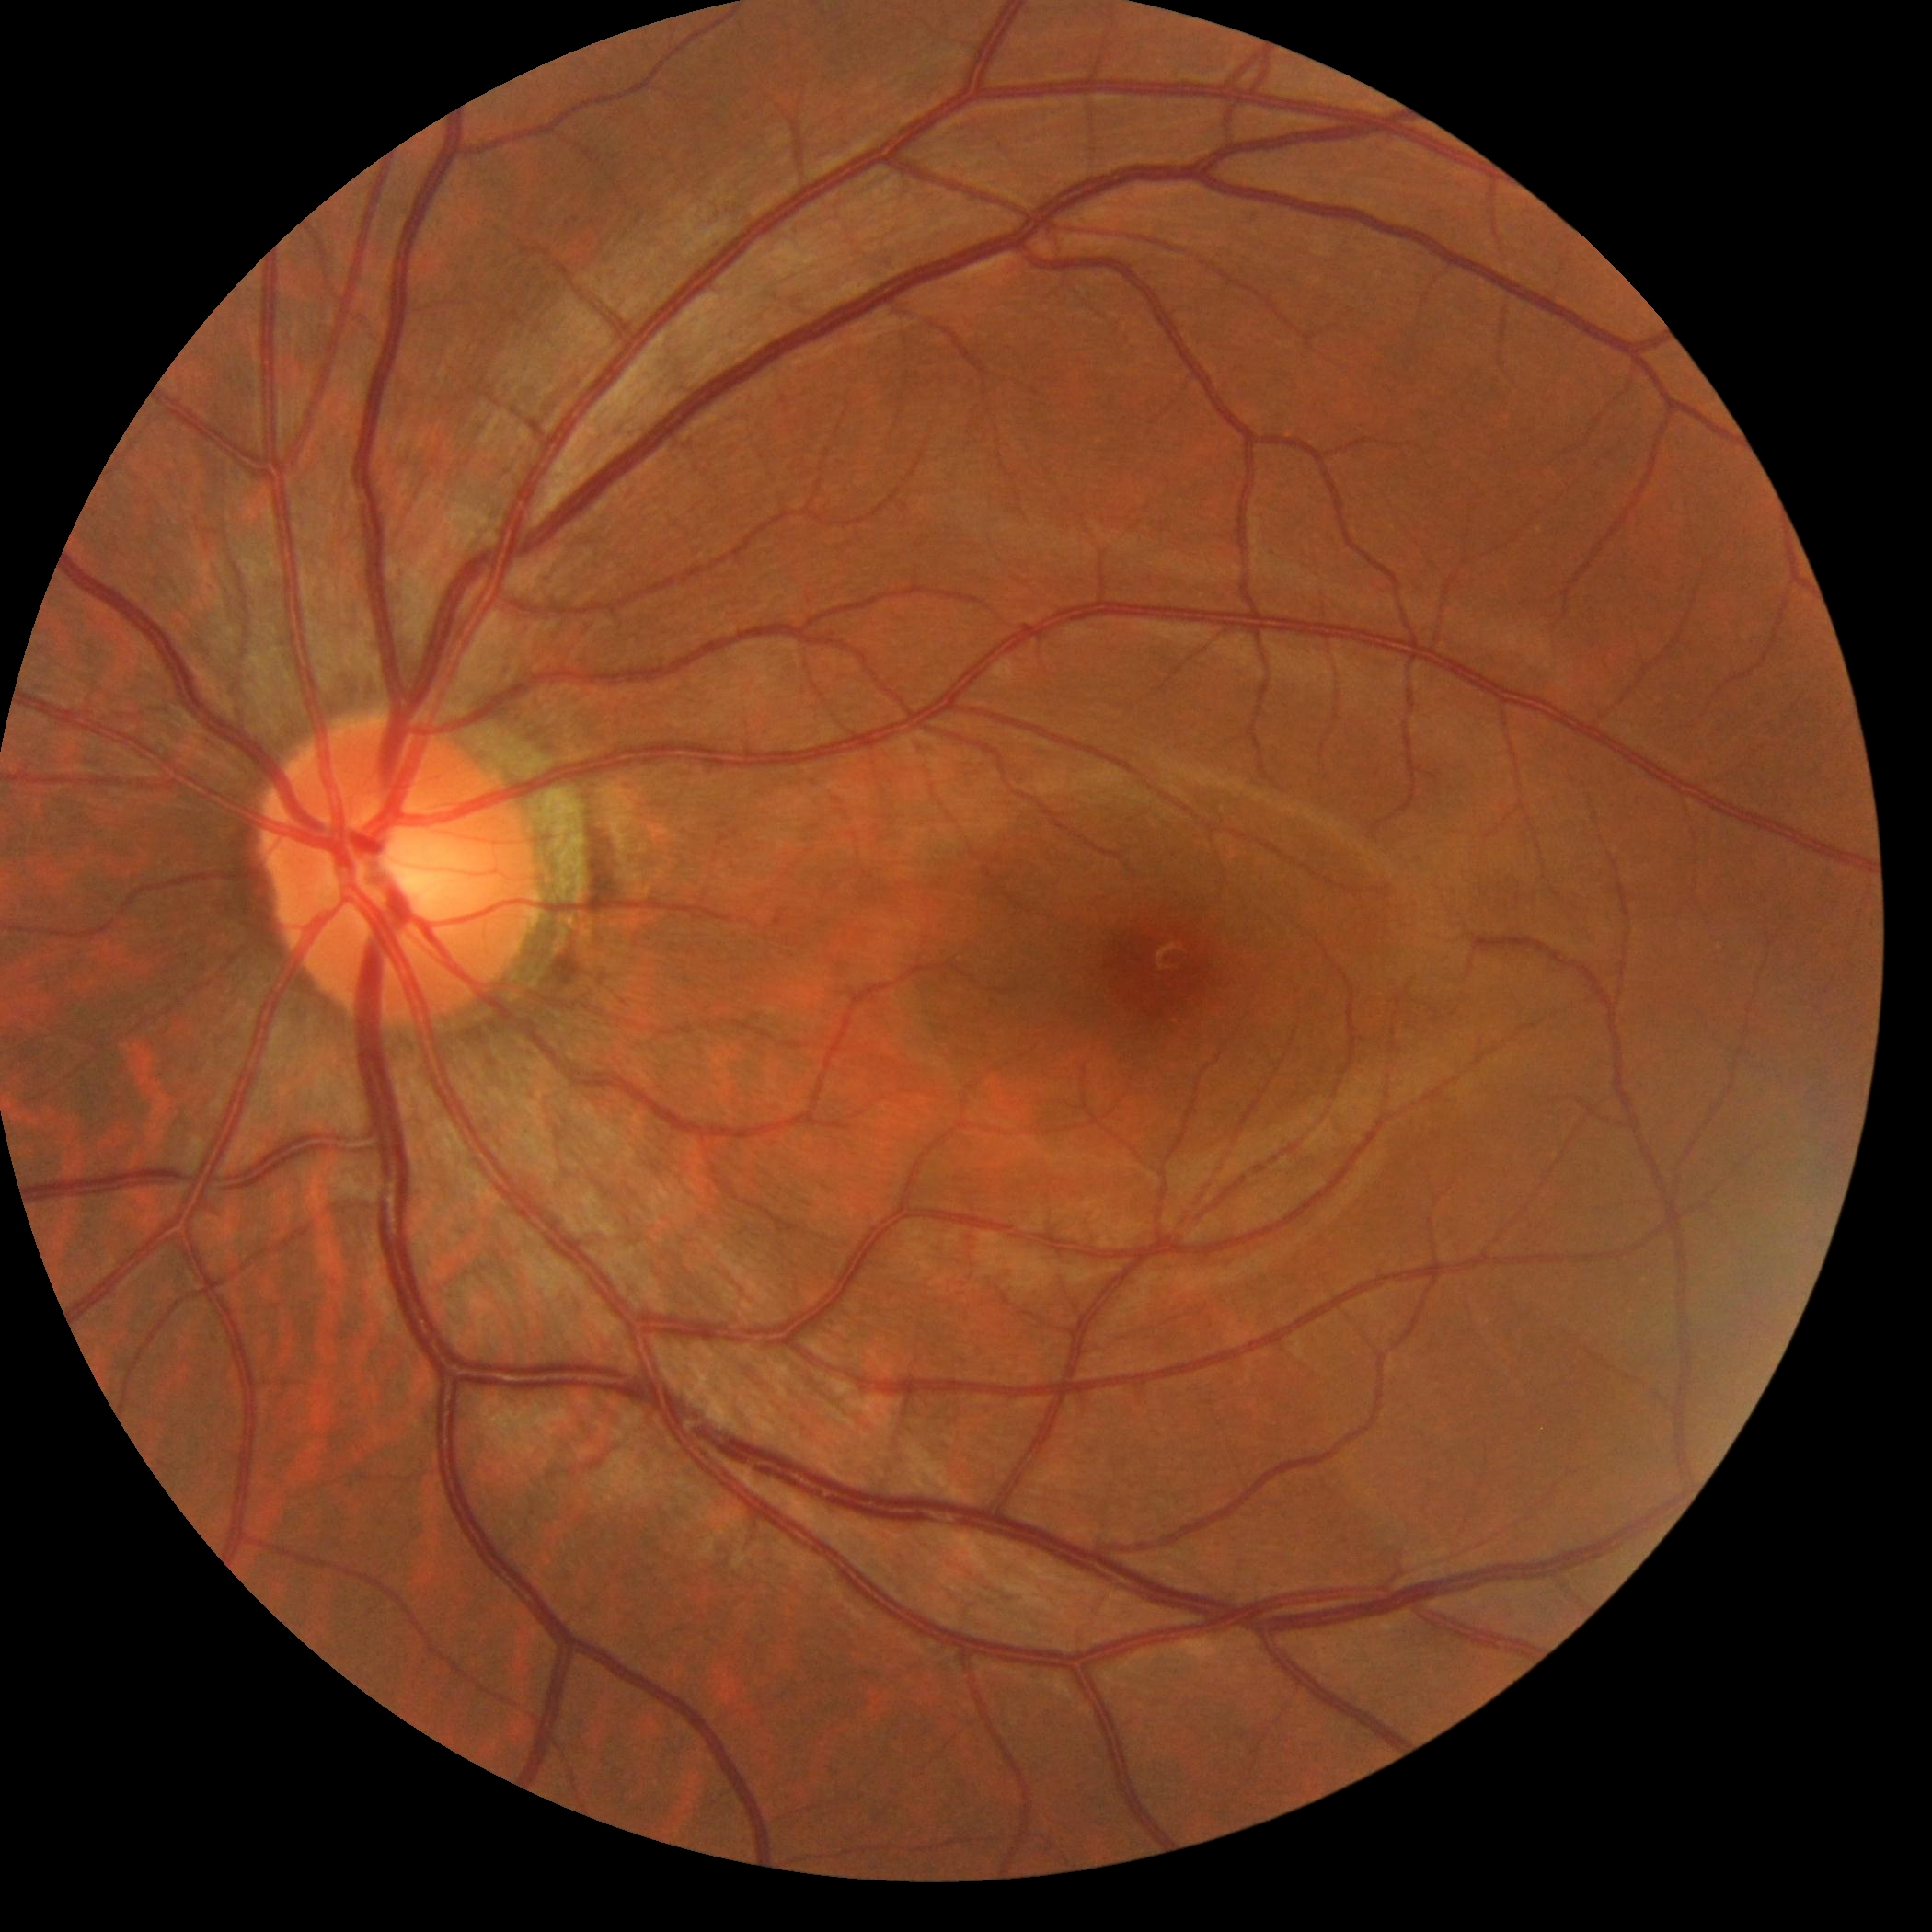 DR is 0/4.
No apparent diabetic retinopathy.